Captured on a Nidek AFC-330 fundus camera.
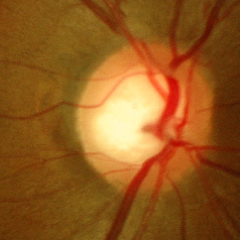
No glaucomatous findings.